FOV: 45 degrees — 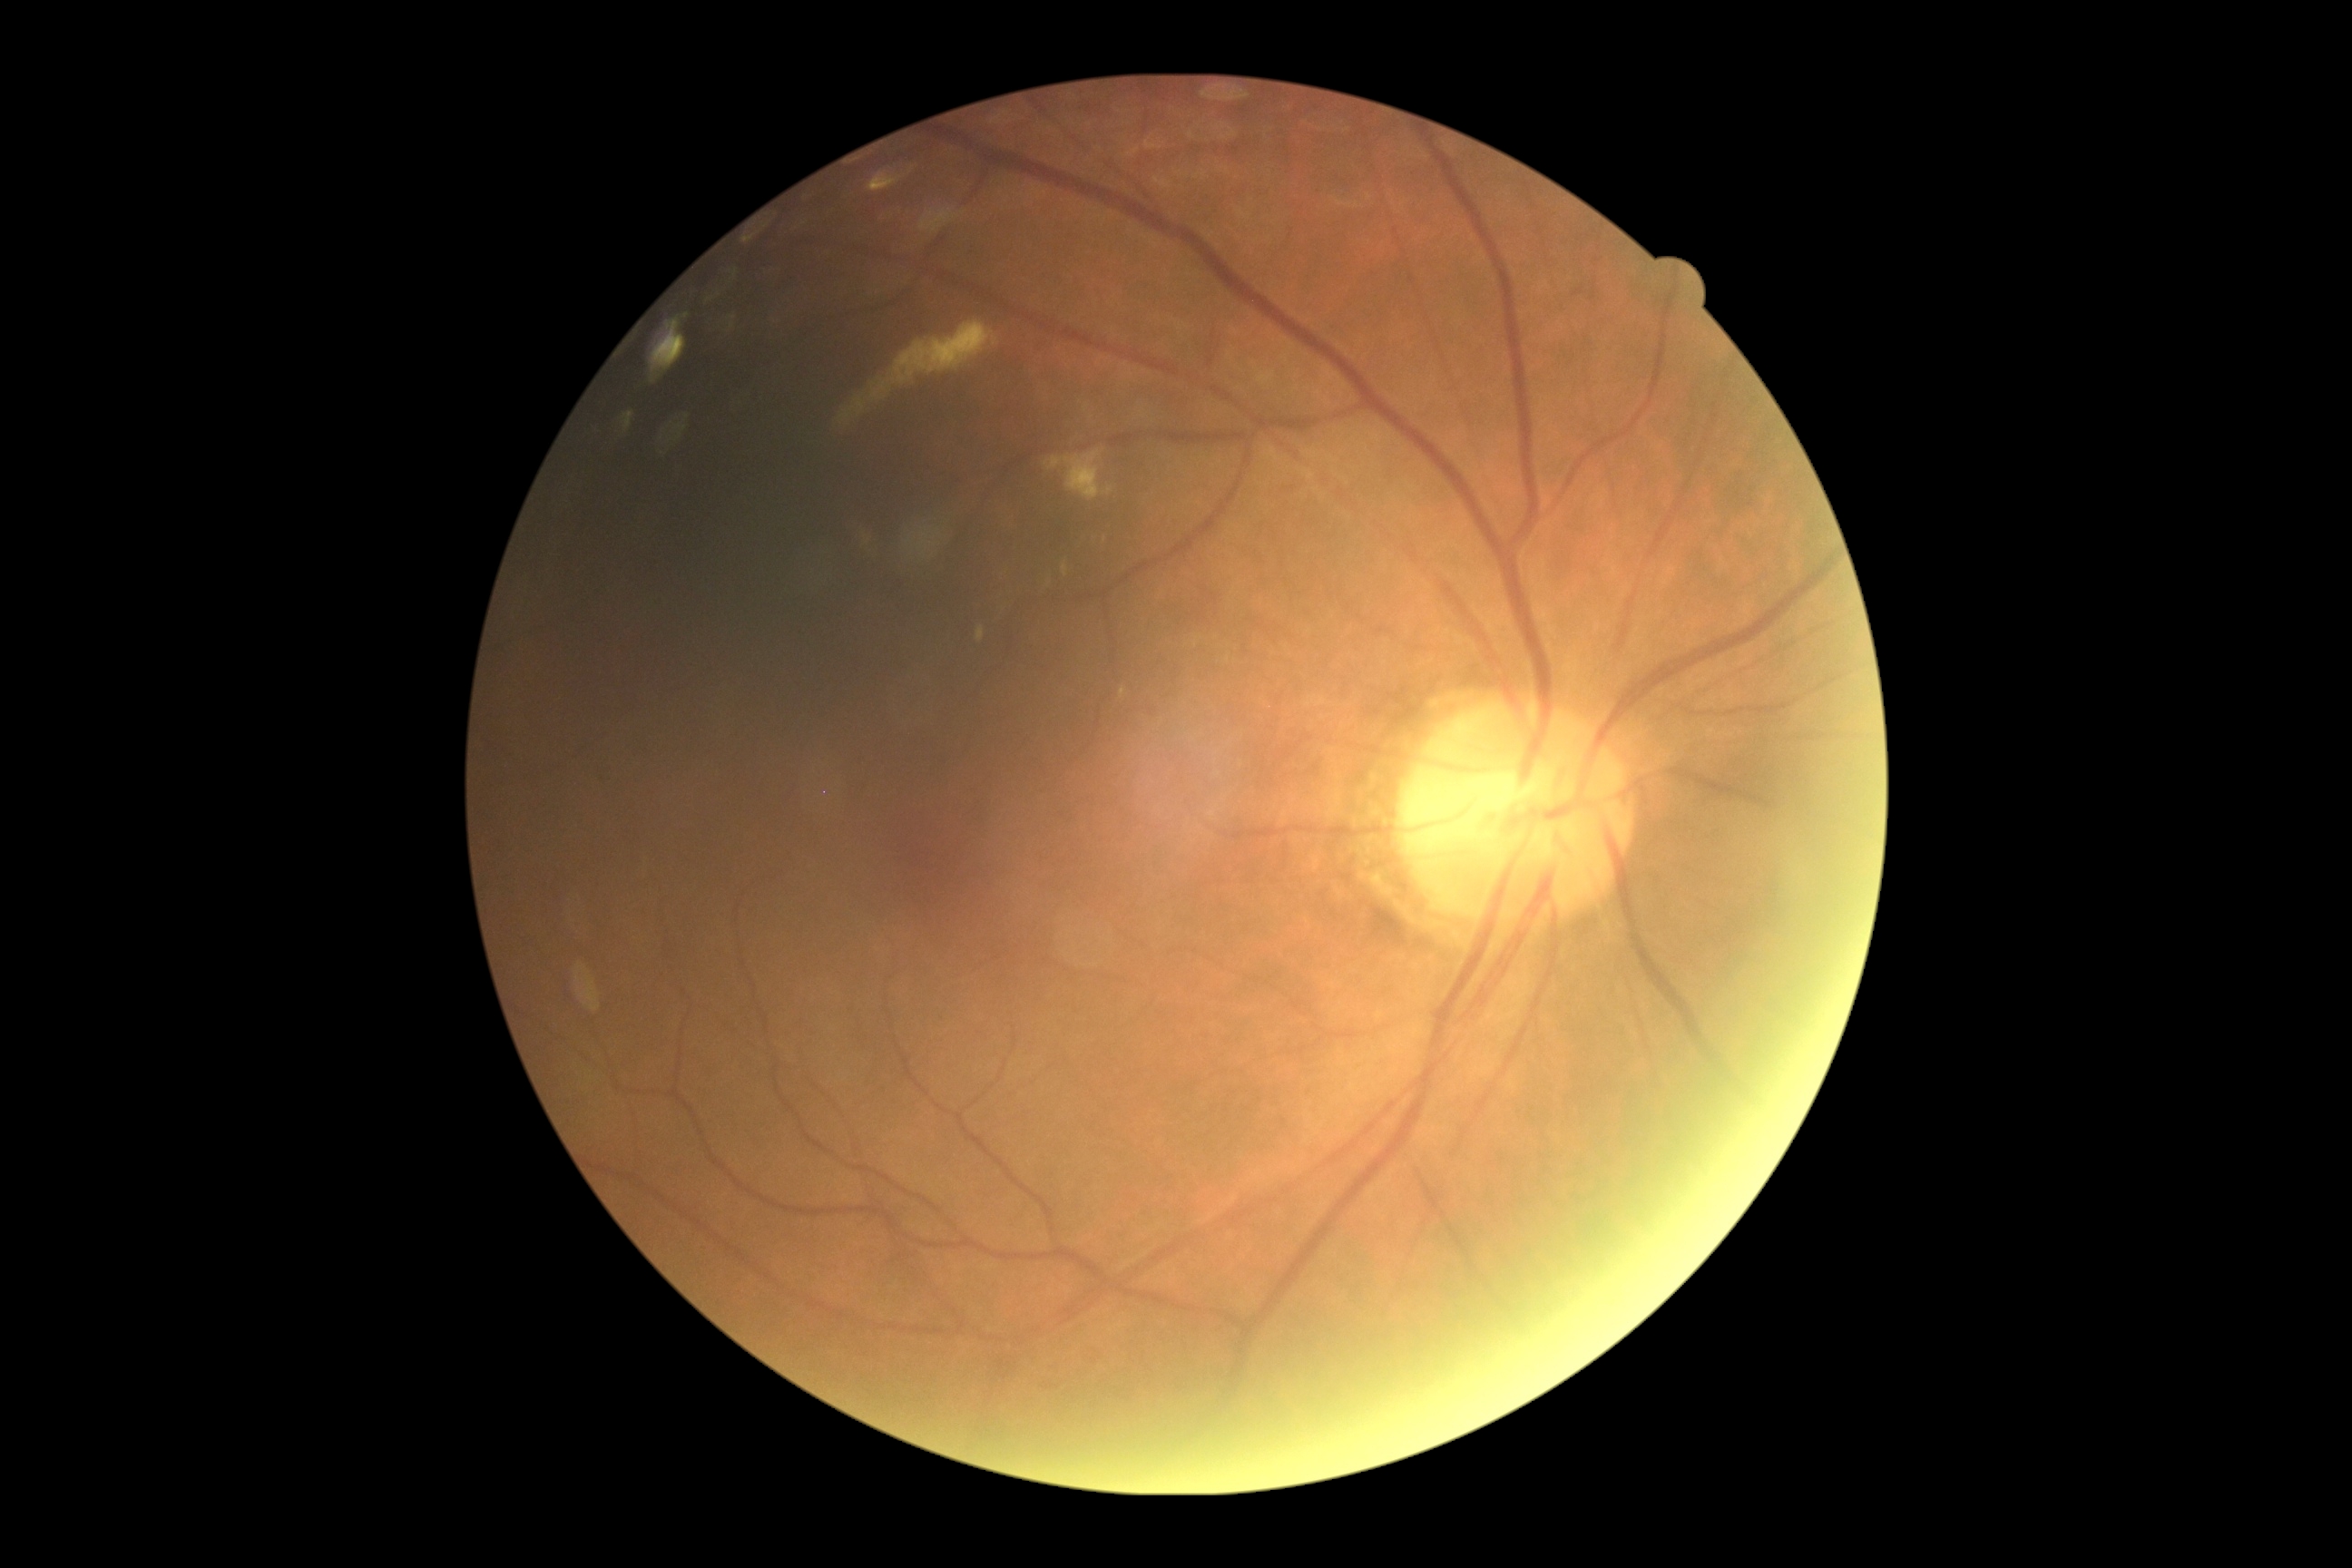
Retinopathy grade: 2 — more than just microaneurysms but less than severe NPDR.
DR class: non-proliferative diabetic retinopathy.